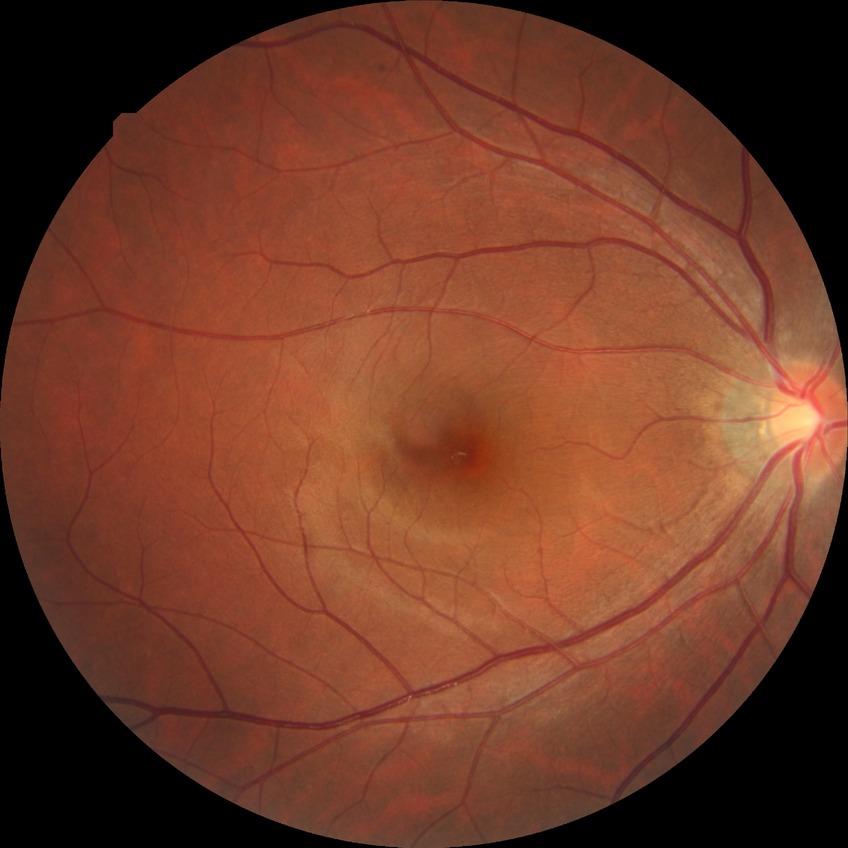
DR impression: no DR findings, modified Davis grade: NDR.